Retinal fundus photograph — 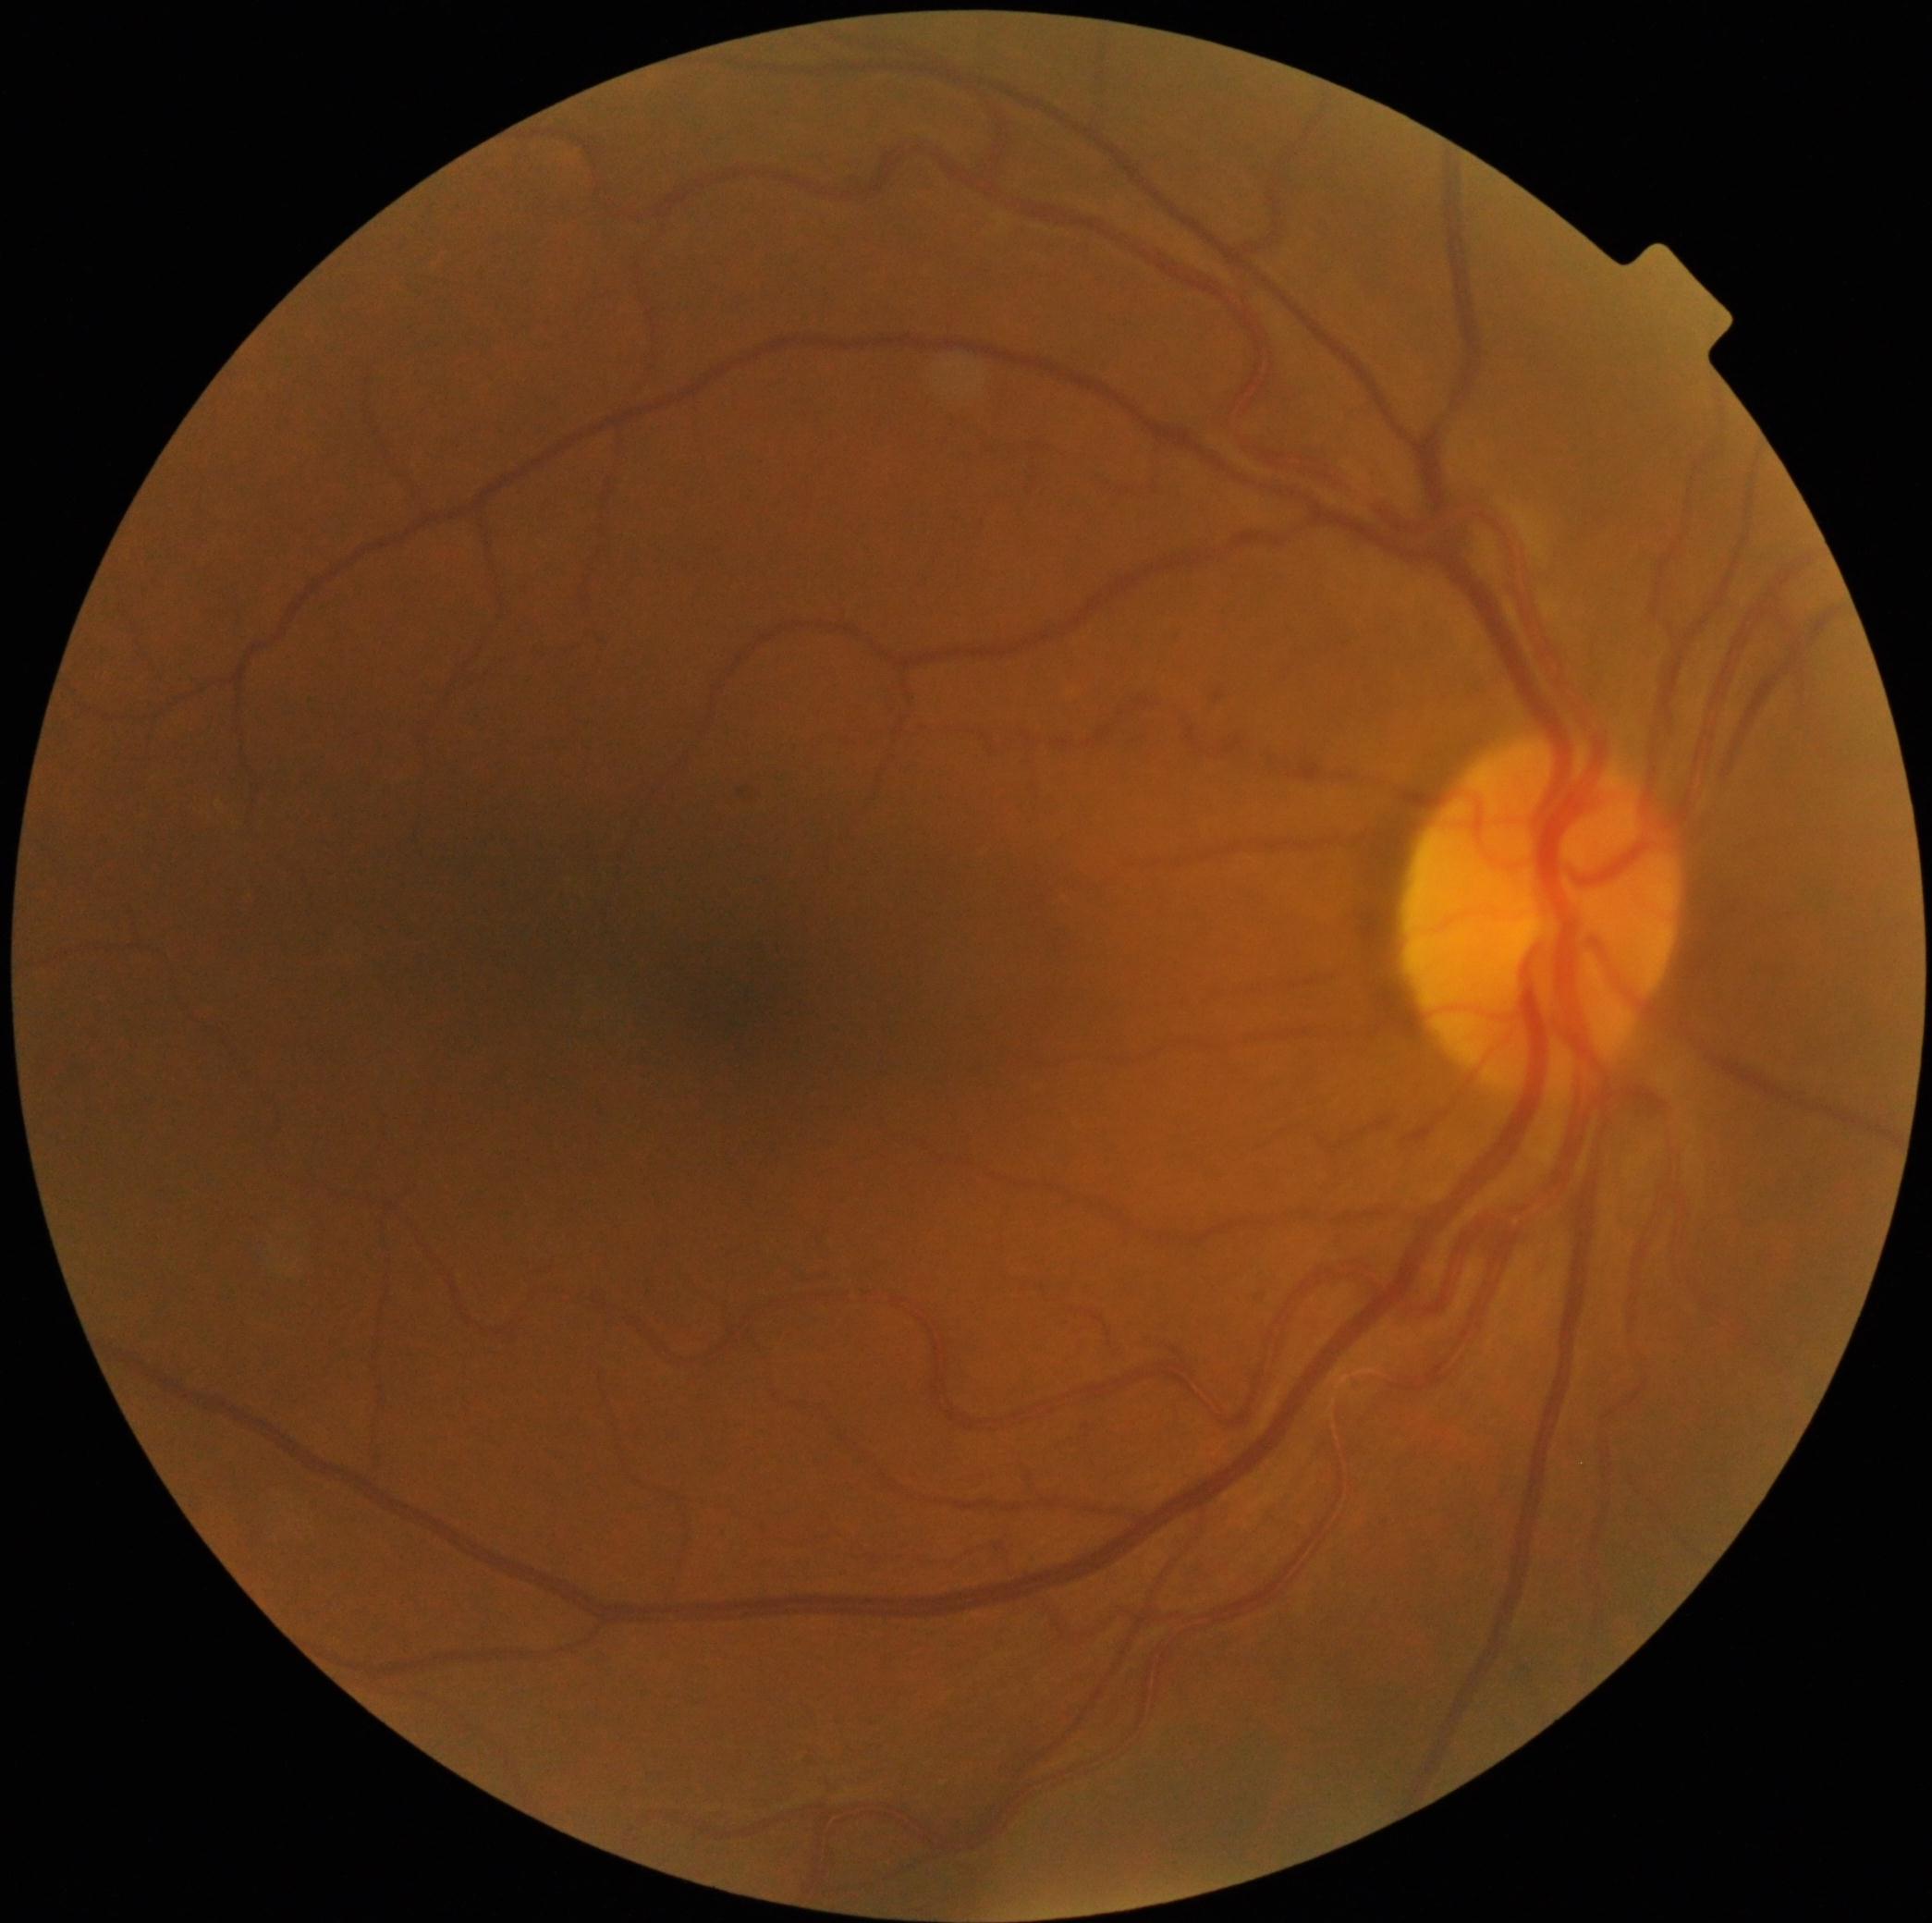

DR impression@no signs of DR; DR severity@grade 0 (no apparent retinopathy).